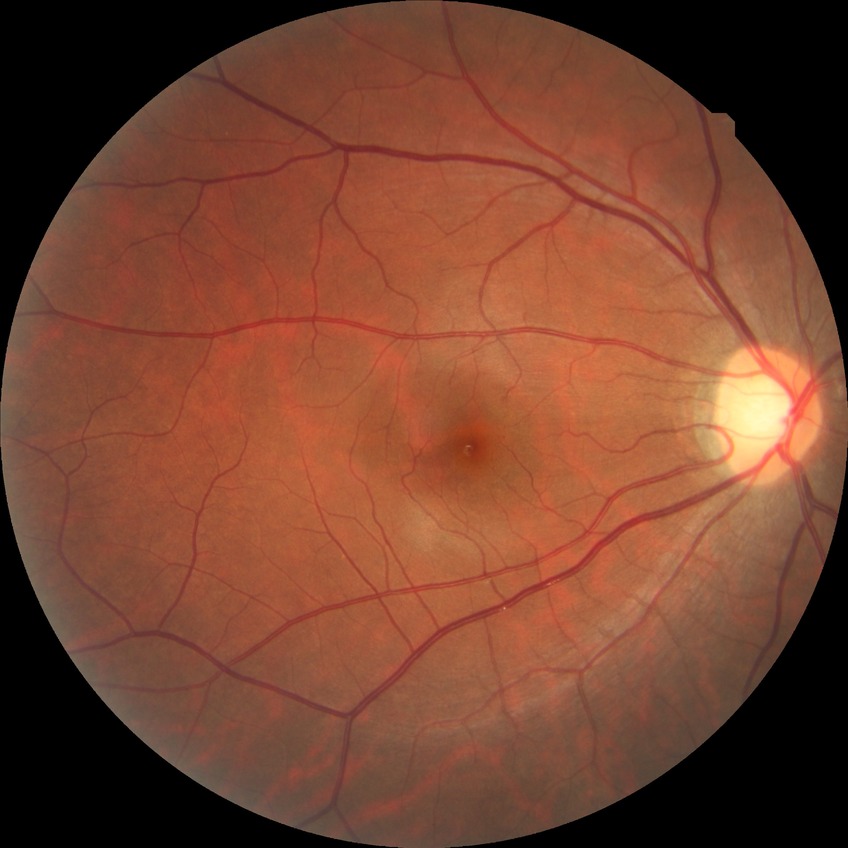

Diabetic retinopathy (DR): NDR (no diabetic retinopathy).